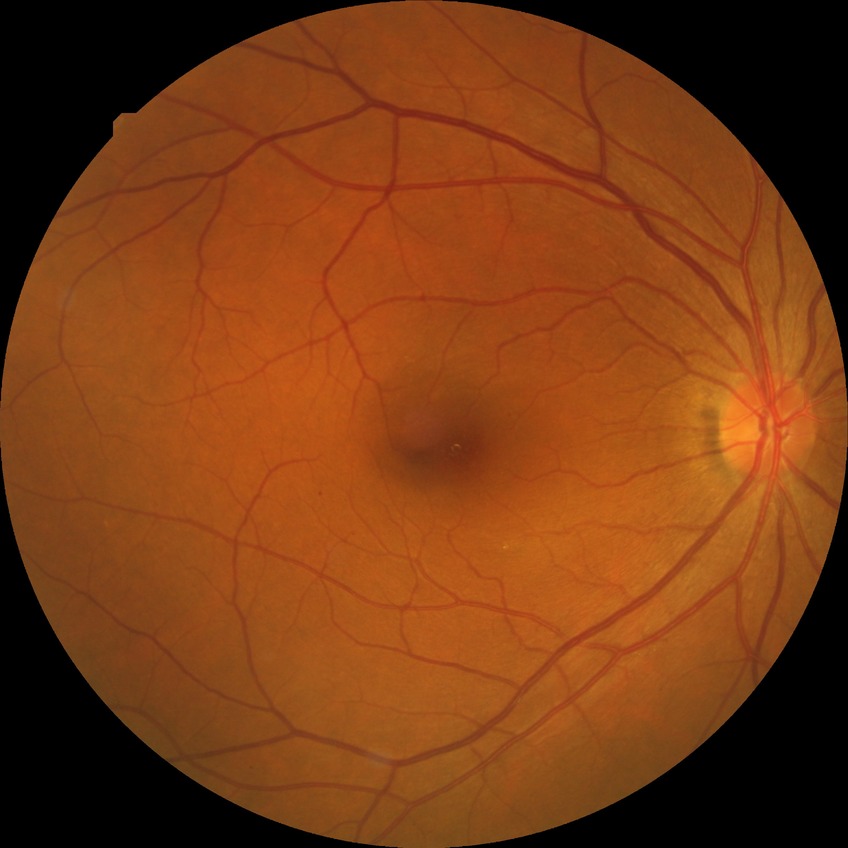

DR is SDR.